Wide-field contact fundus photograph of an infant. 100° field of view (Phoenix ICON):
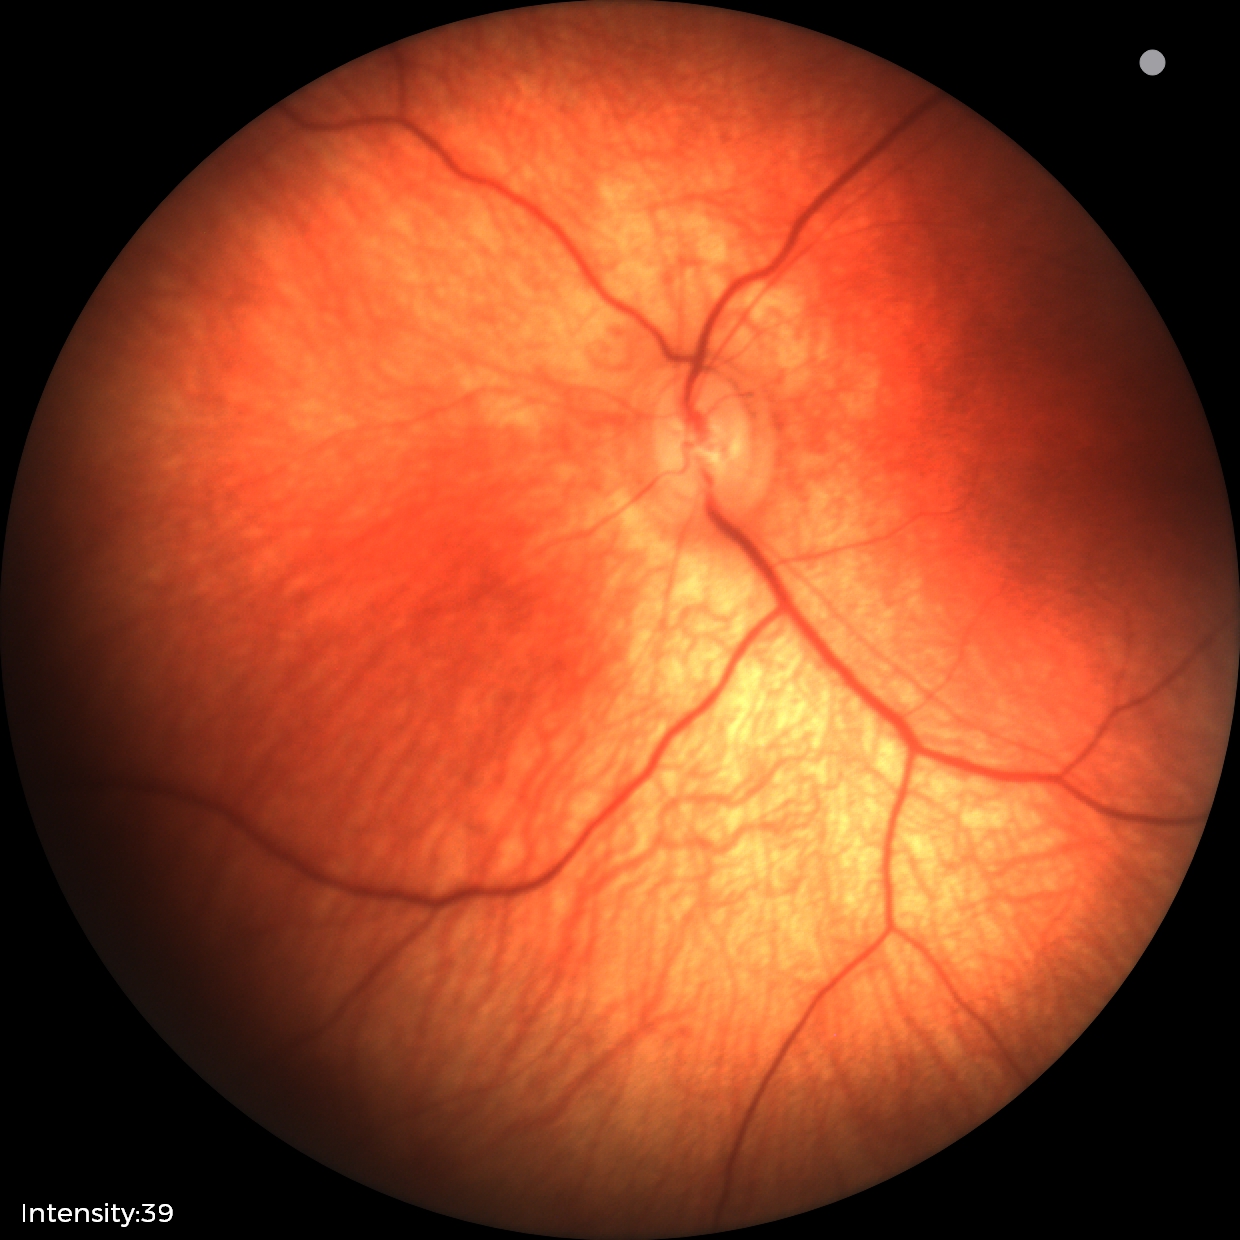

No retinal pathology identified on screening.